Color fundus photograph, 1725x1721px, 45° field of view: 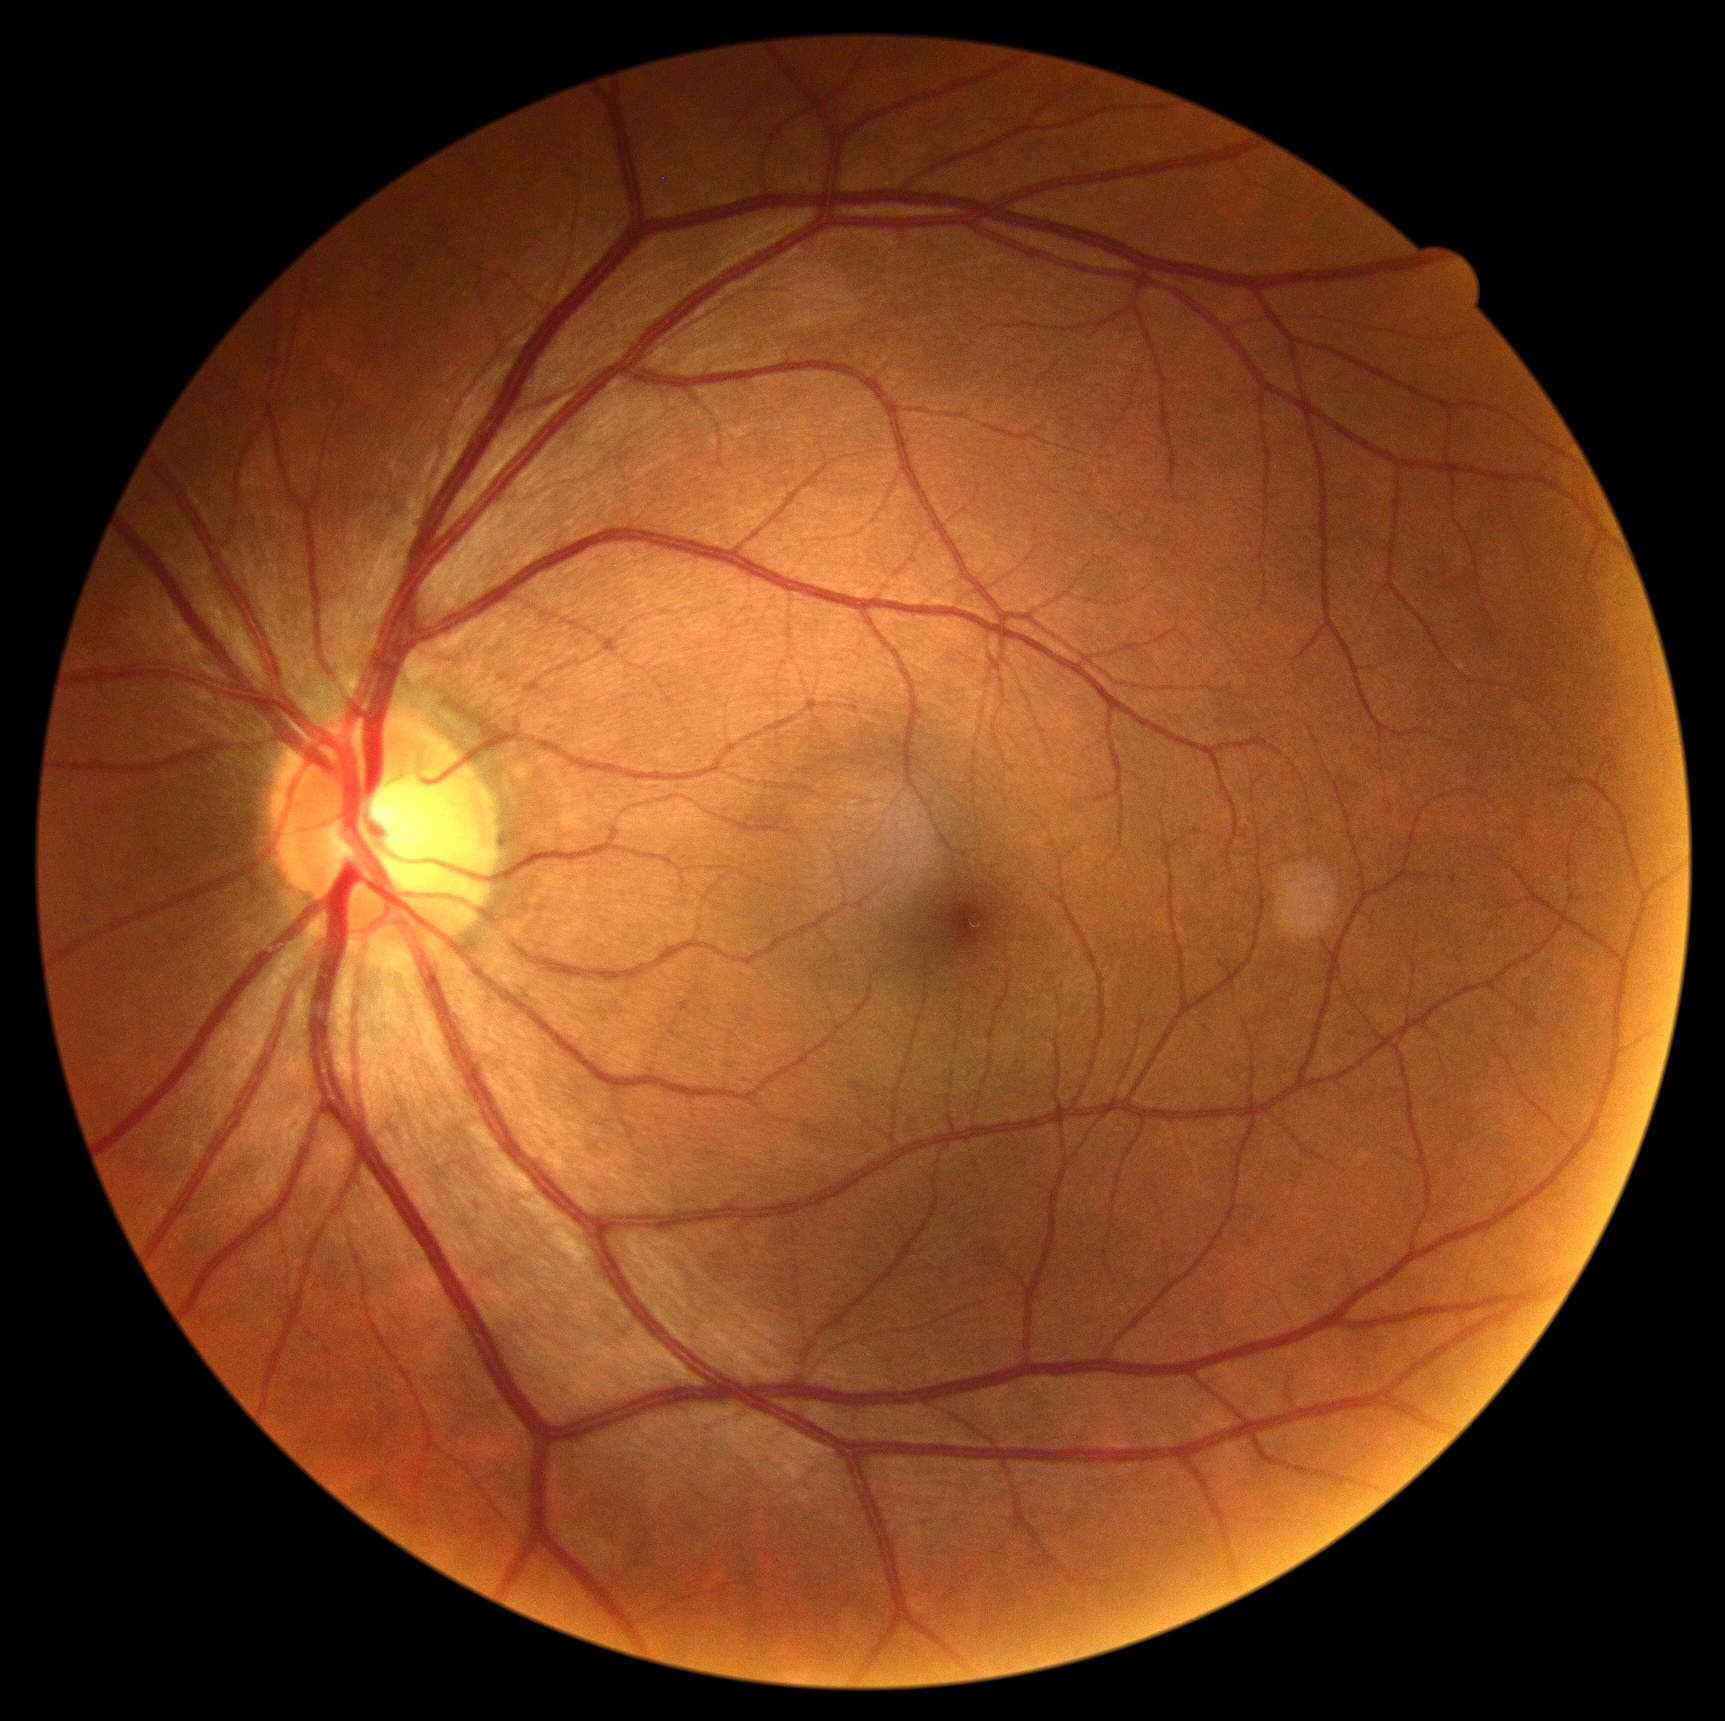 {"dr_grade": "0 (no apparent retinopathy)"}